Camera: Nidek AFC-330.
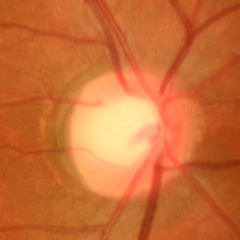 This fundus photograph shows no glaucomatous changes.